Non-mydriatic, 240 by 240 pixels, captured on a Nidek AFC-330 fundus camera.
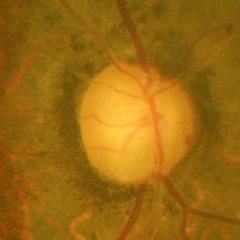

Q: Glaucoma assessment?
A: Advanced glaucoma. Defined as near-total cupping of the optic nerve head, with or without severe visual field loss within the central 10 degrees of fixation.